Image size 2352x1568, color fundus image: 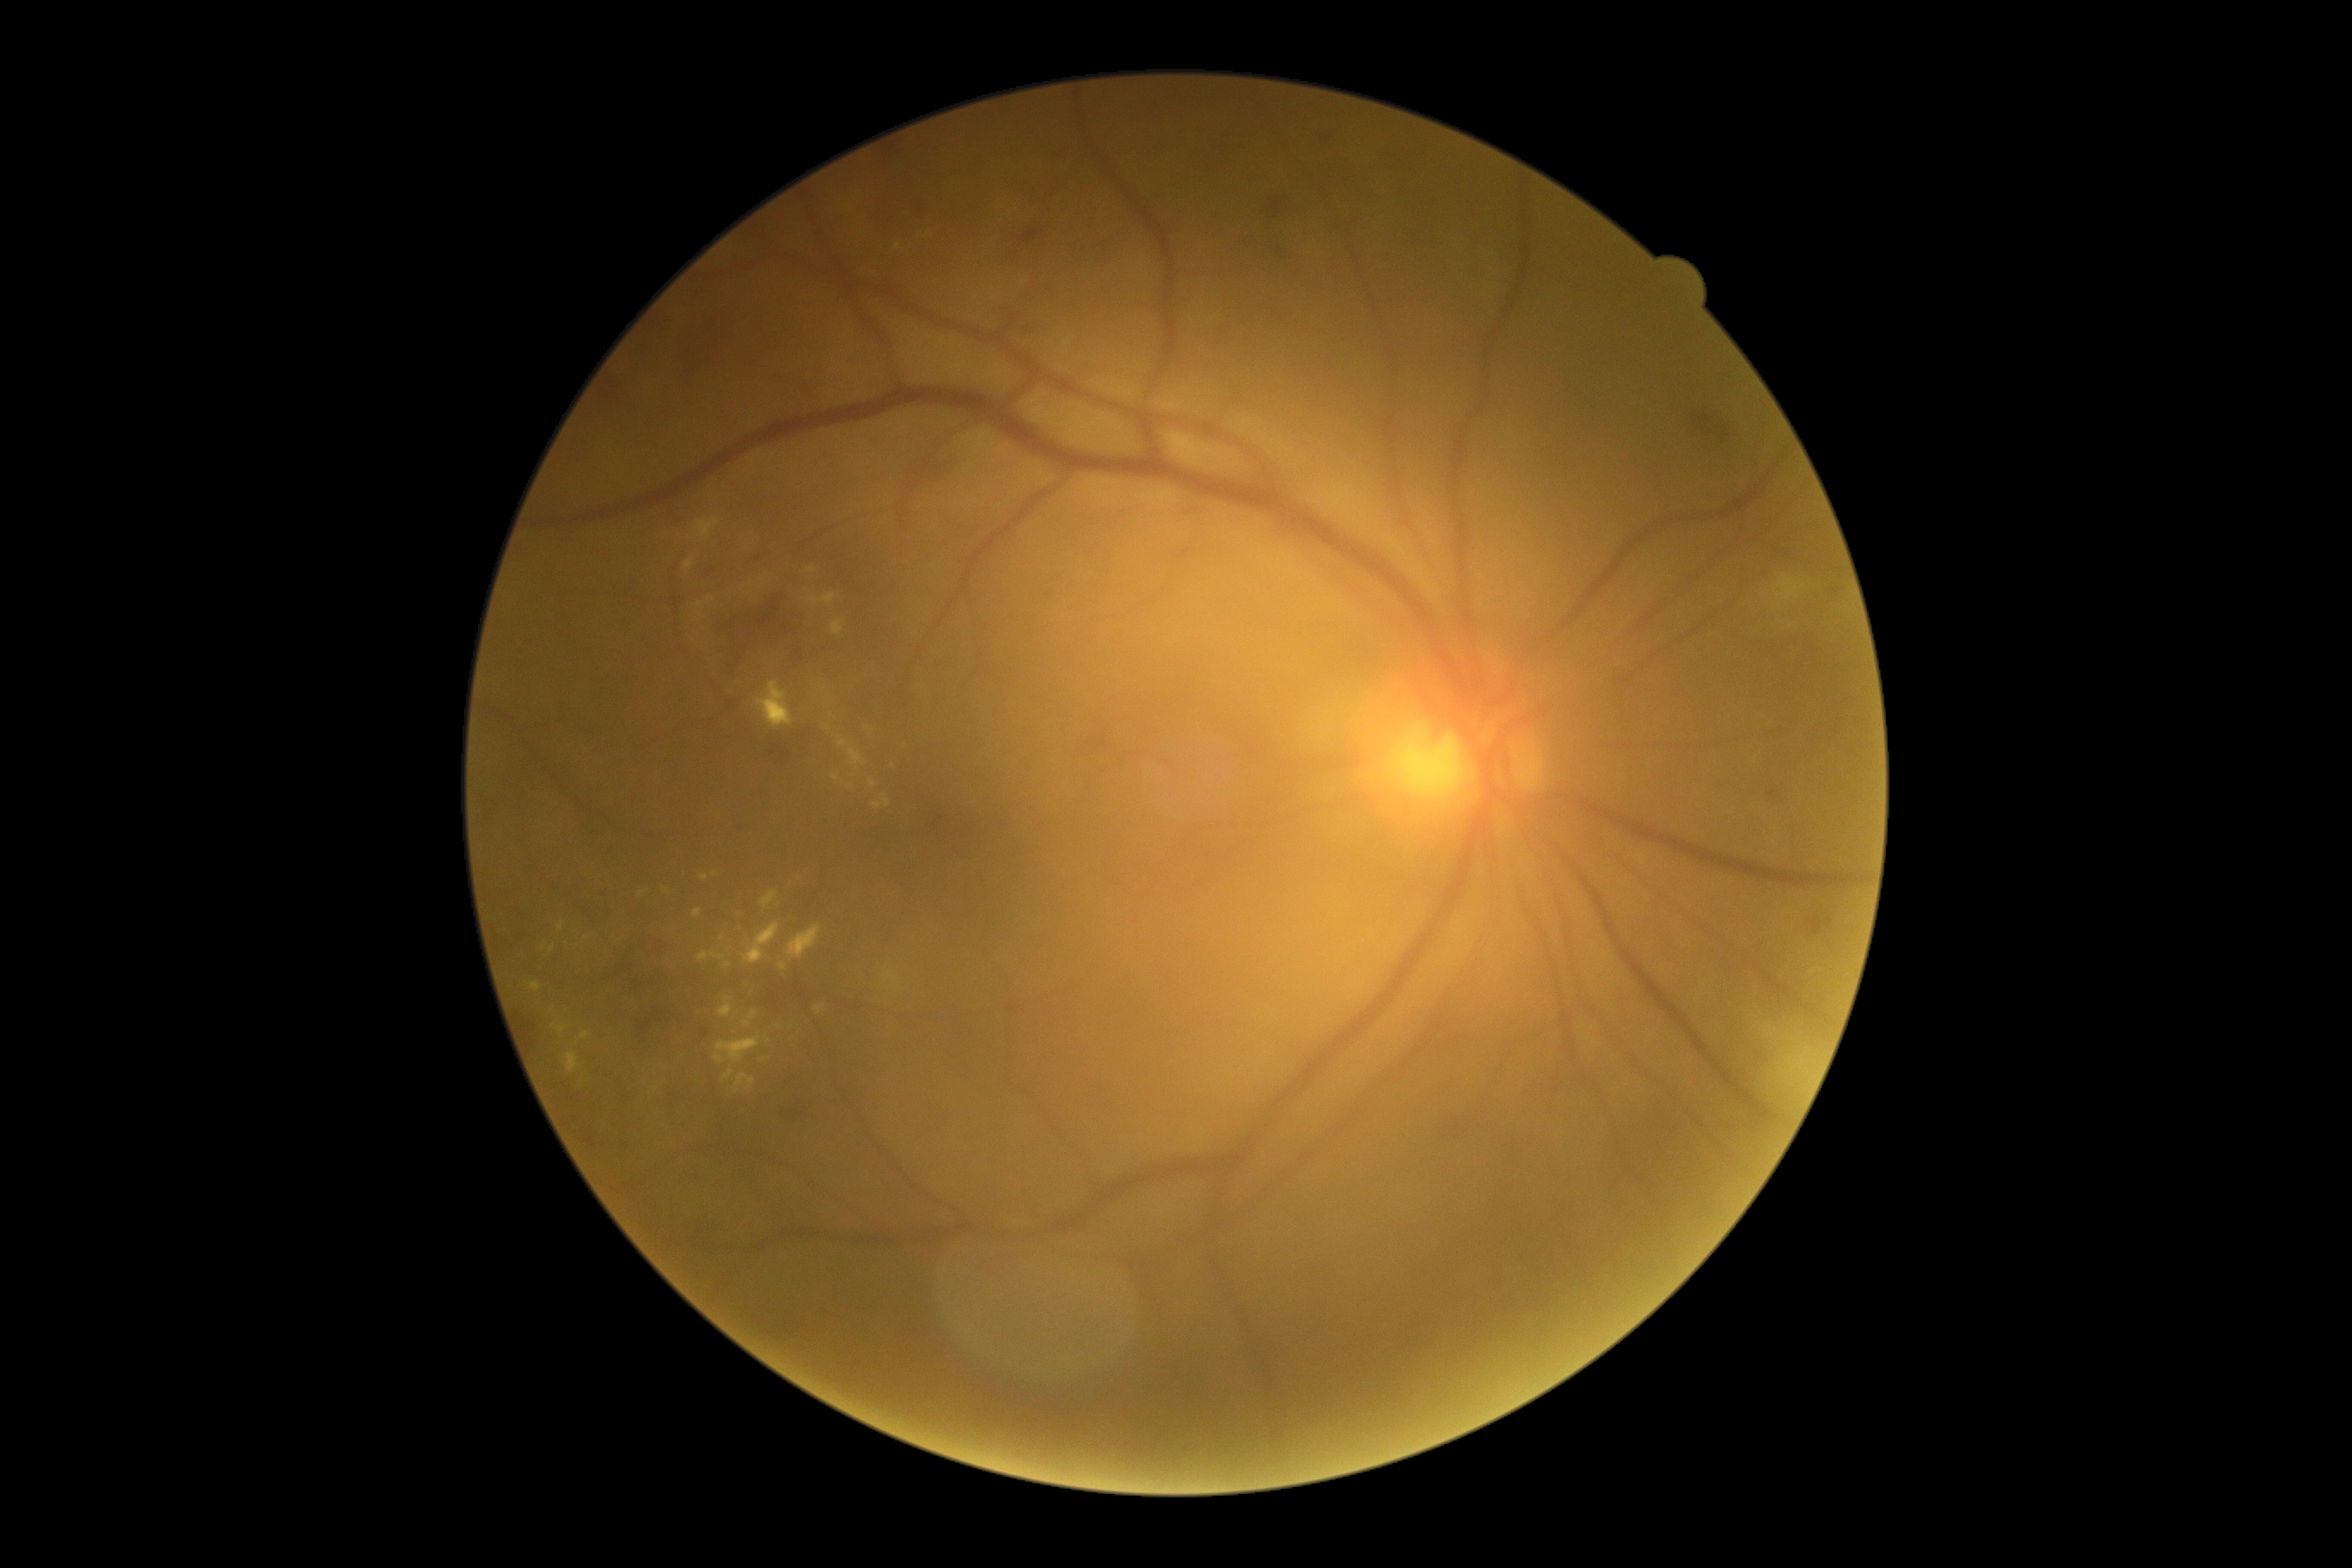 Annotations:
• DR class: non-proliferative diabetic retinopathy
• DR severity: 2/4